45° field of view, CFP:
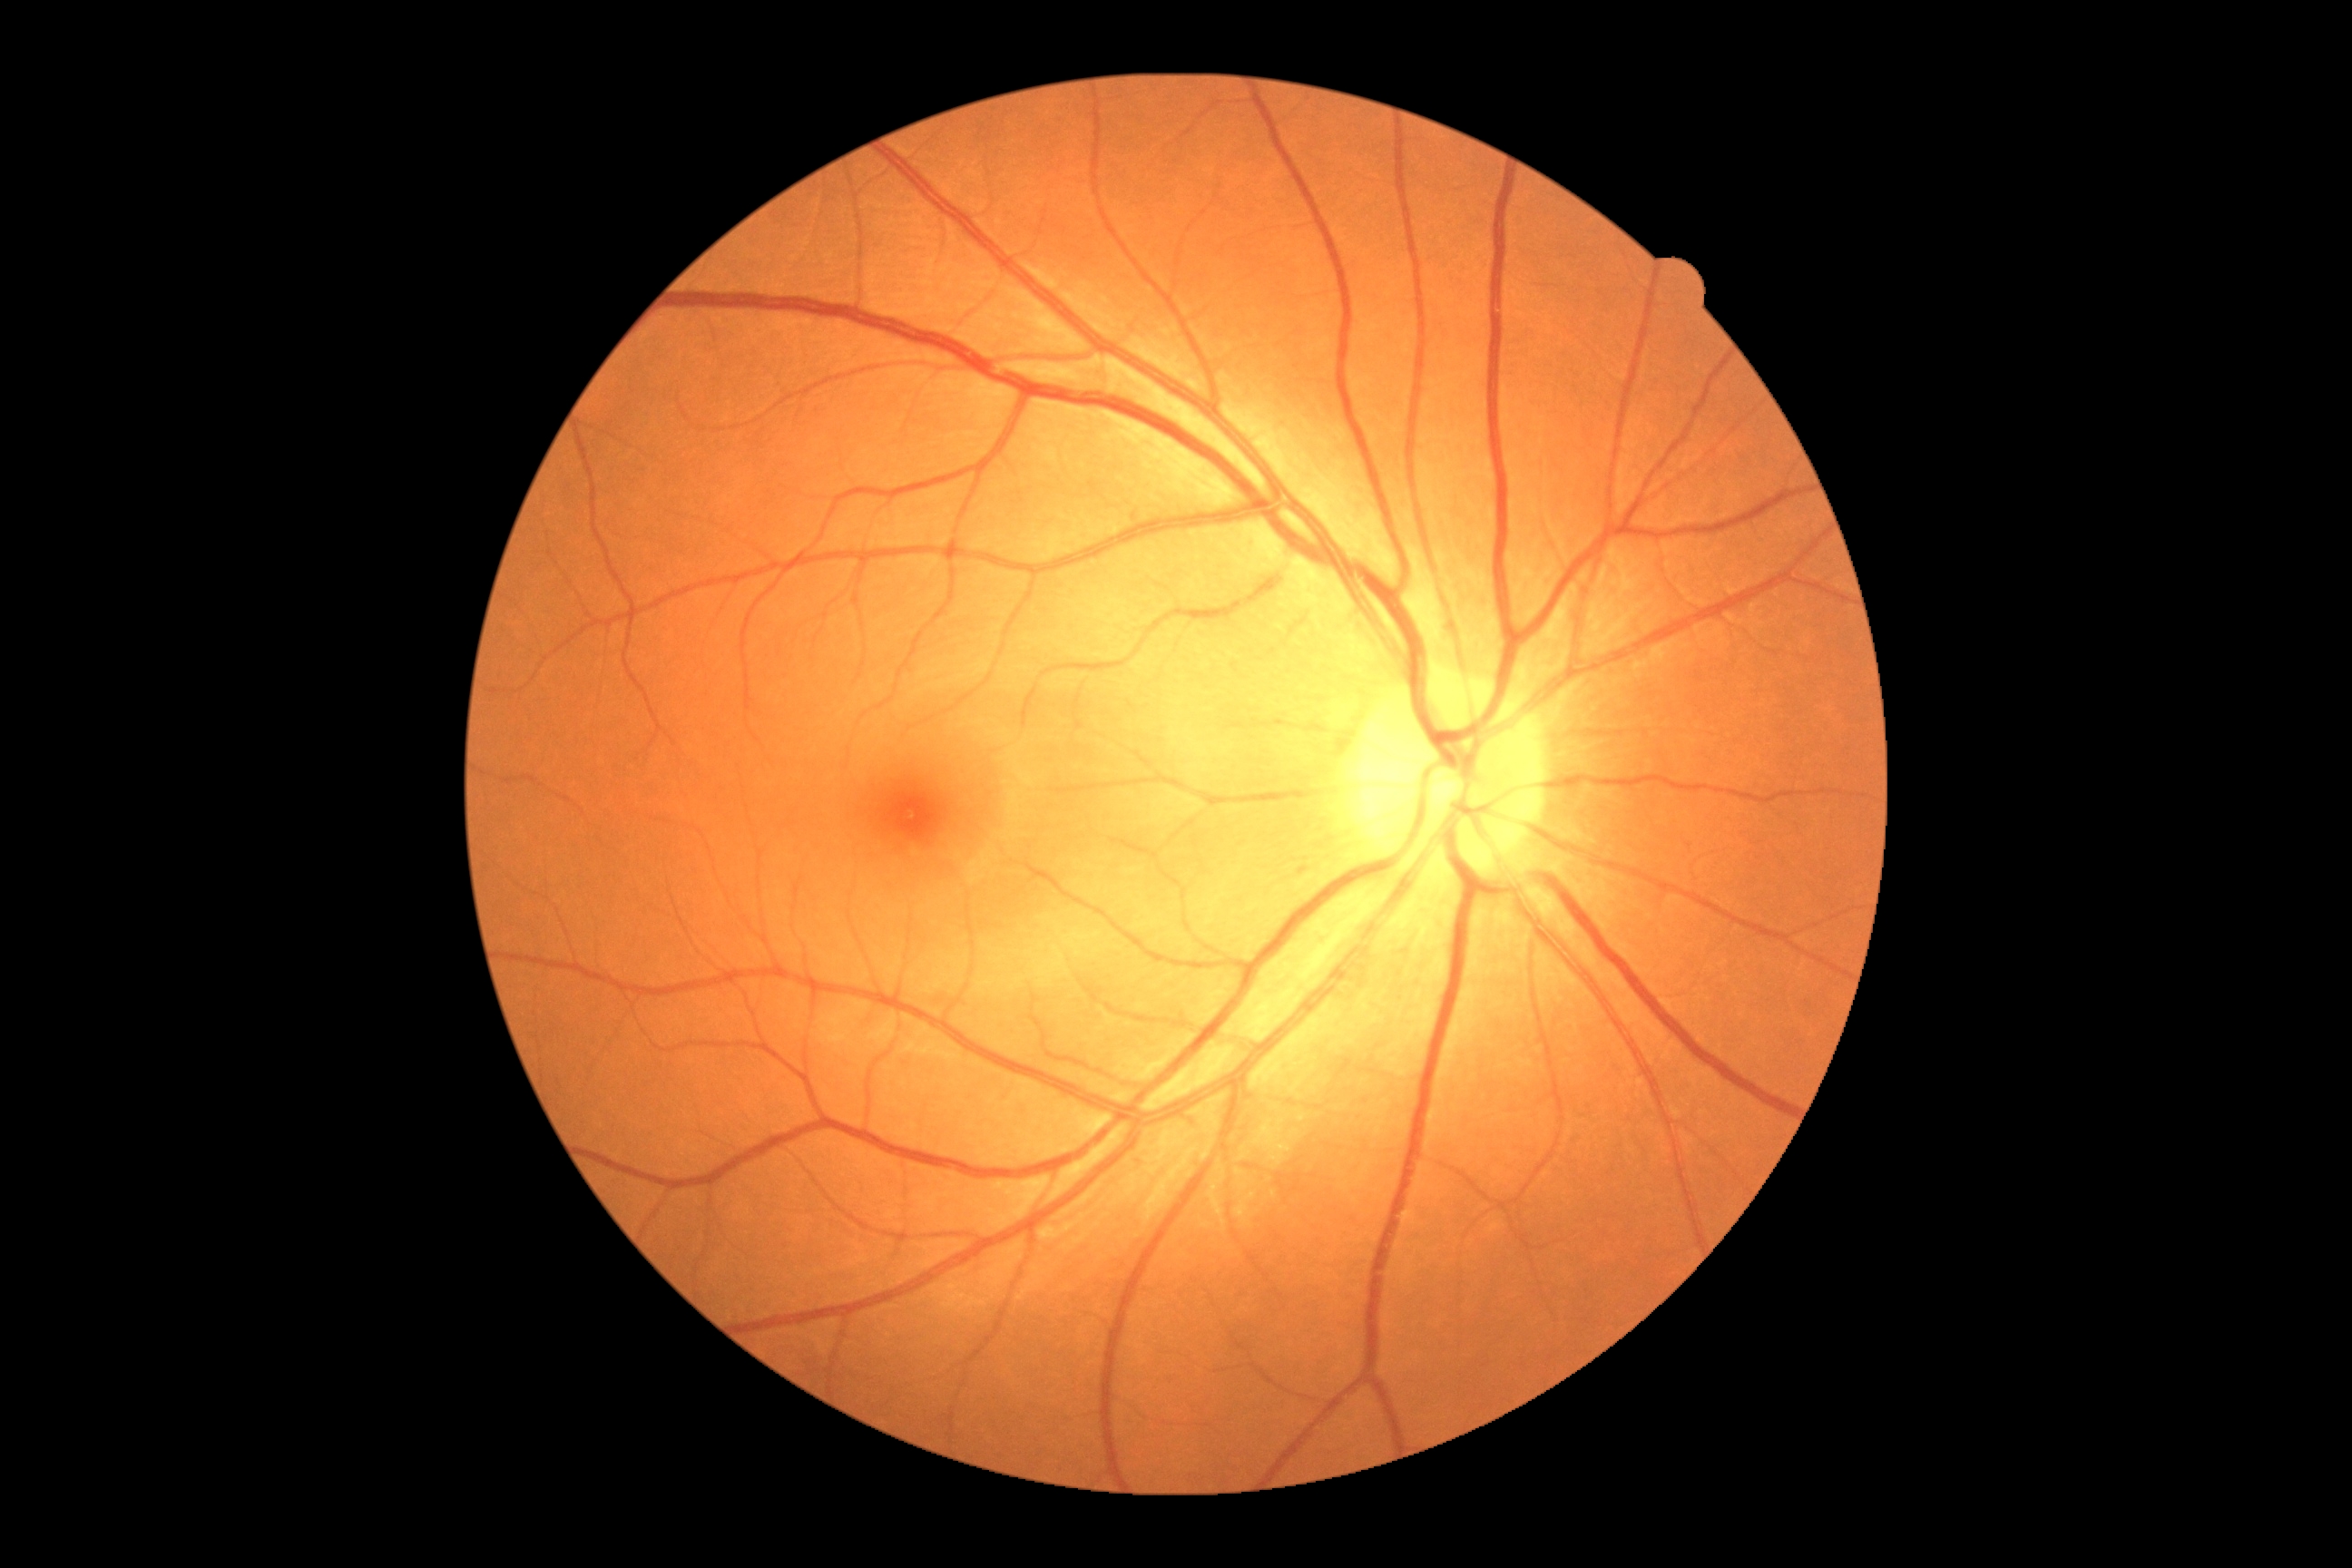 DR impression = no apparent DR; DR = no apparent diabetic retinopathy (grade 0).